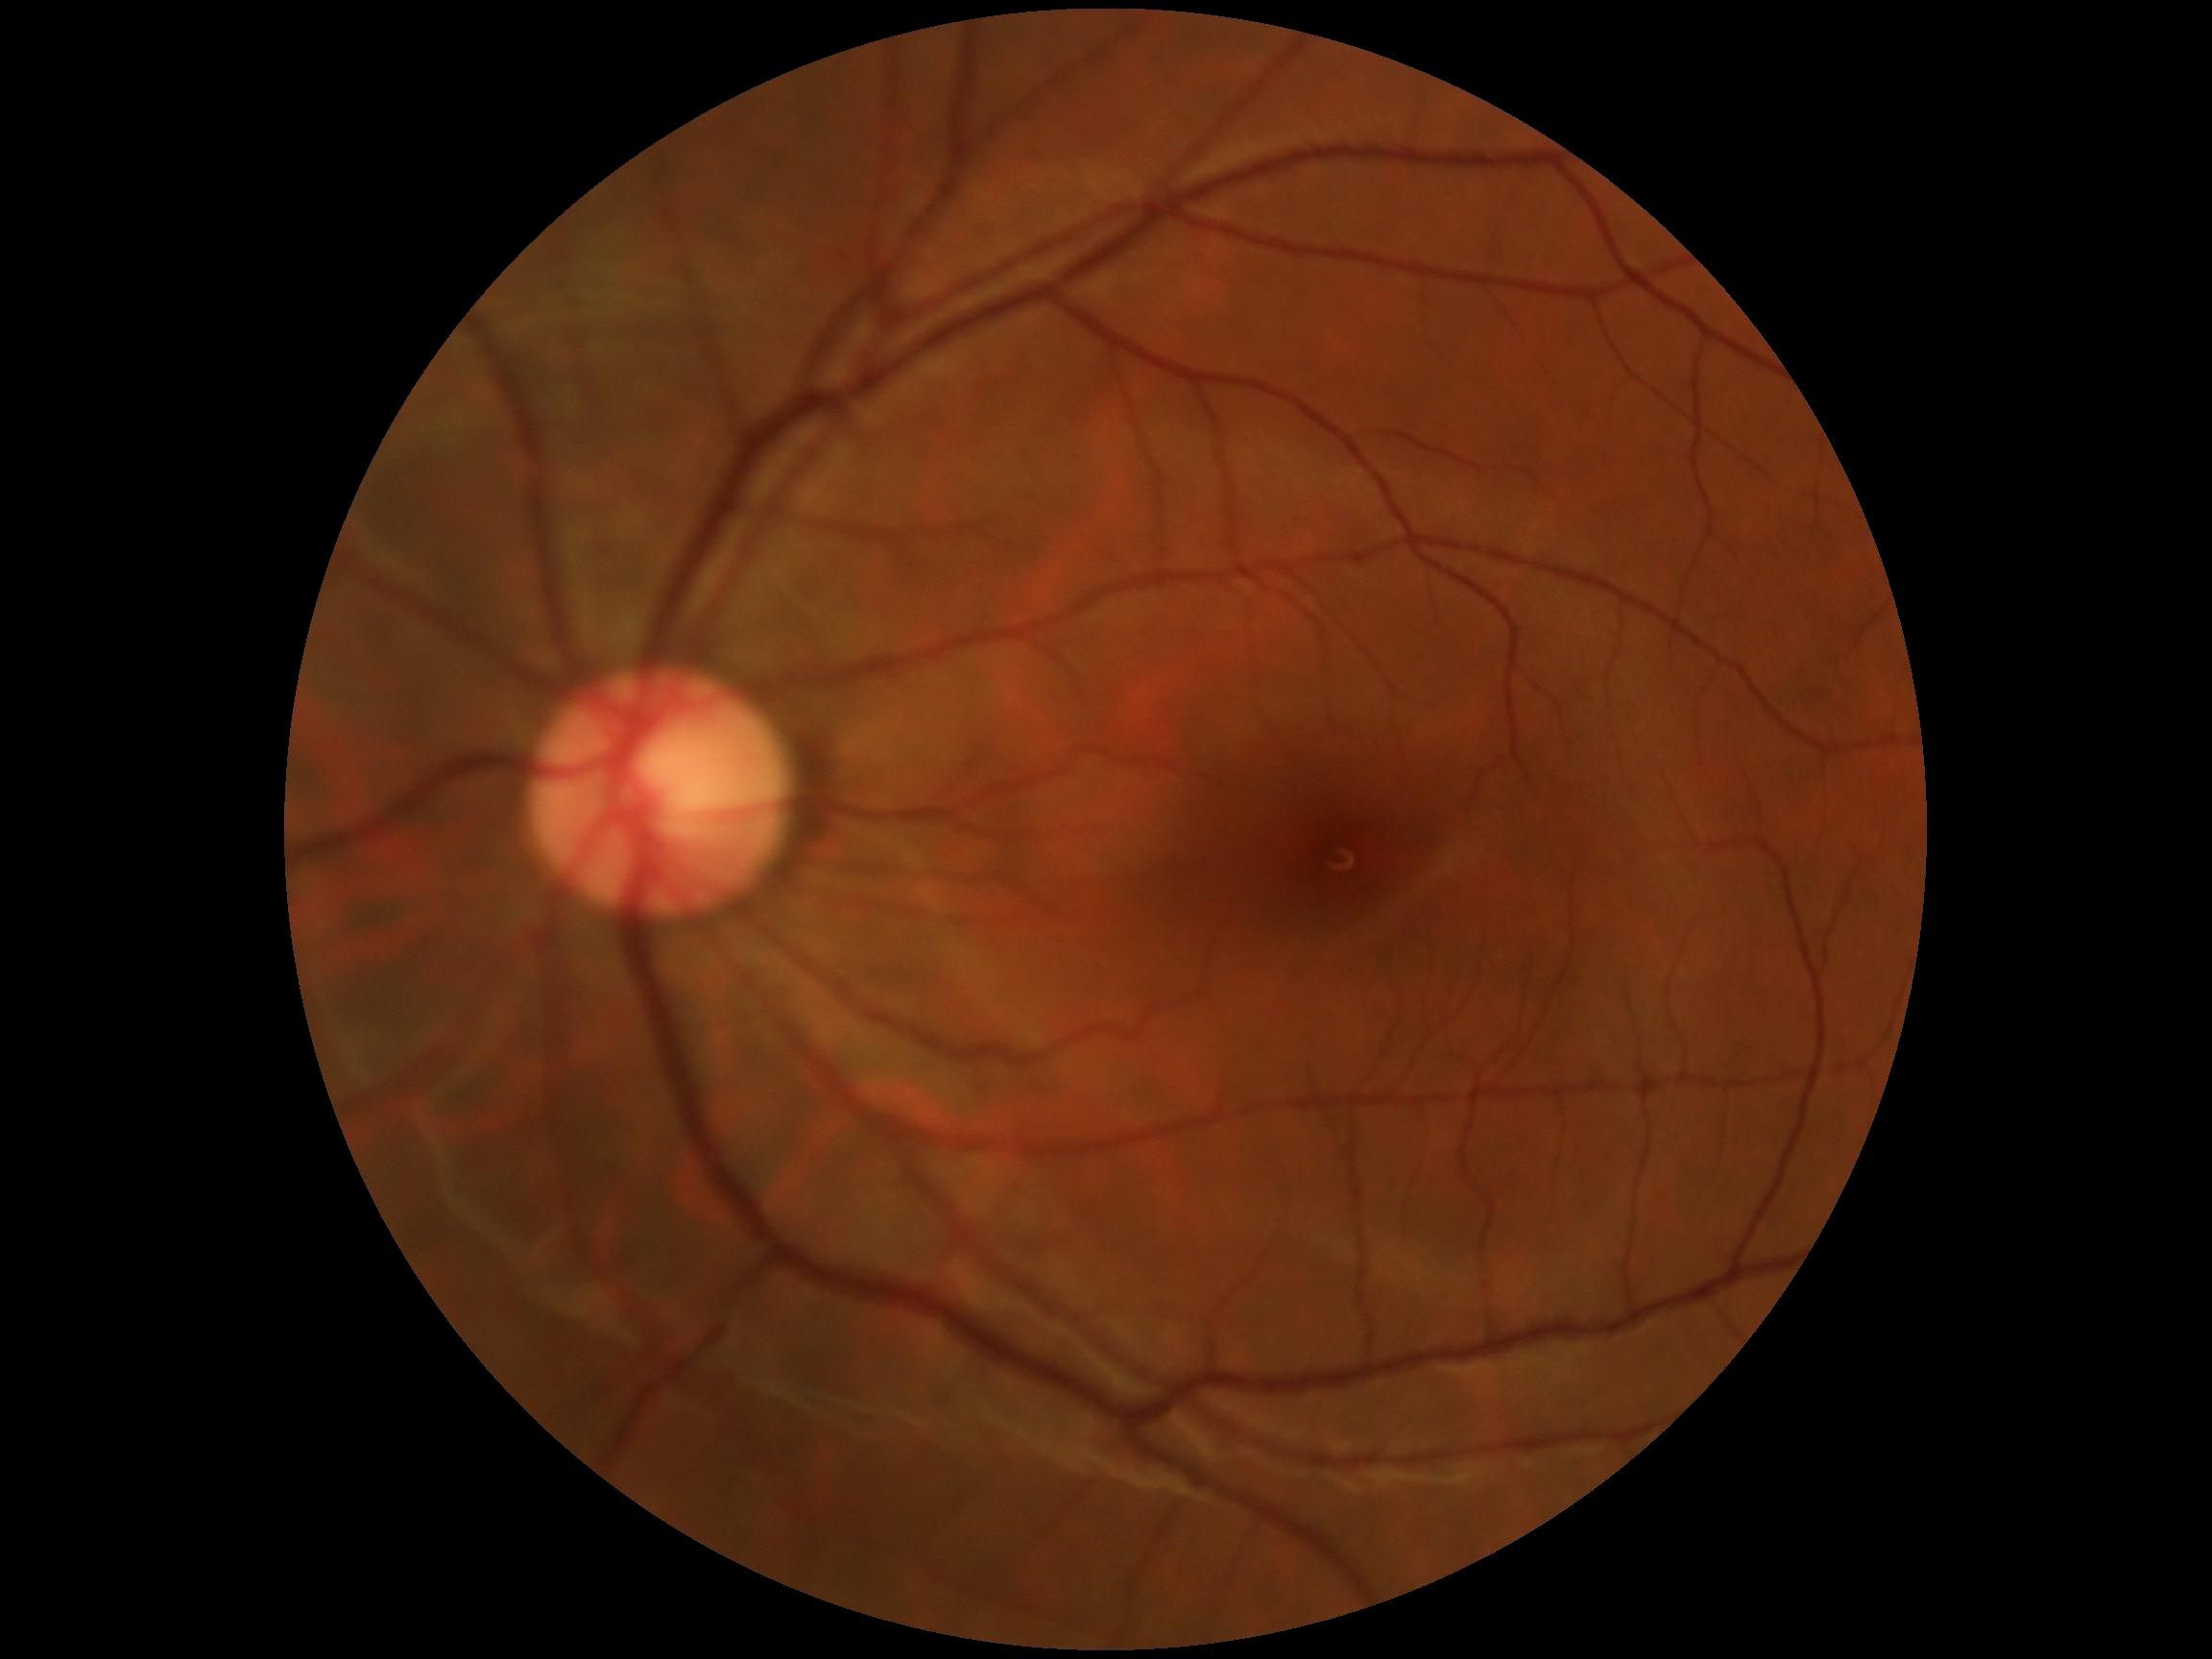
* DR severity — no apparent retinopathy (grade 0)